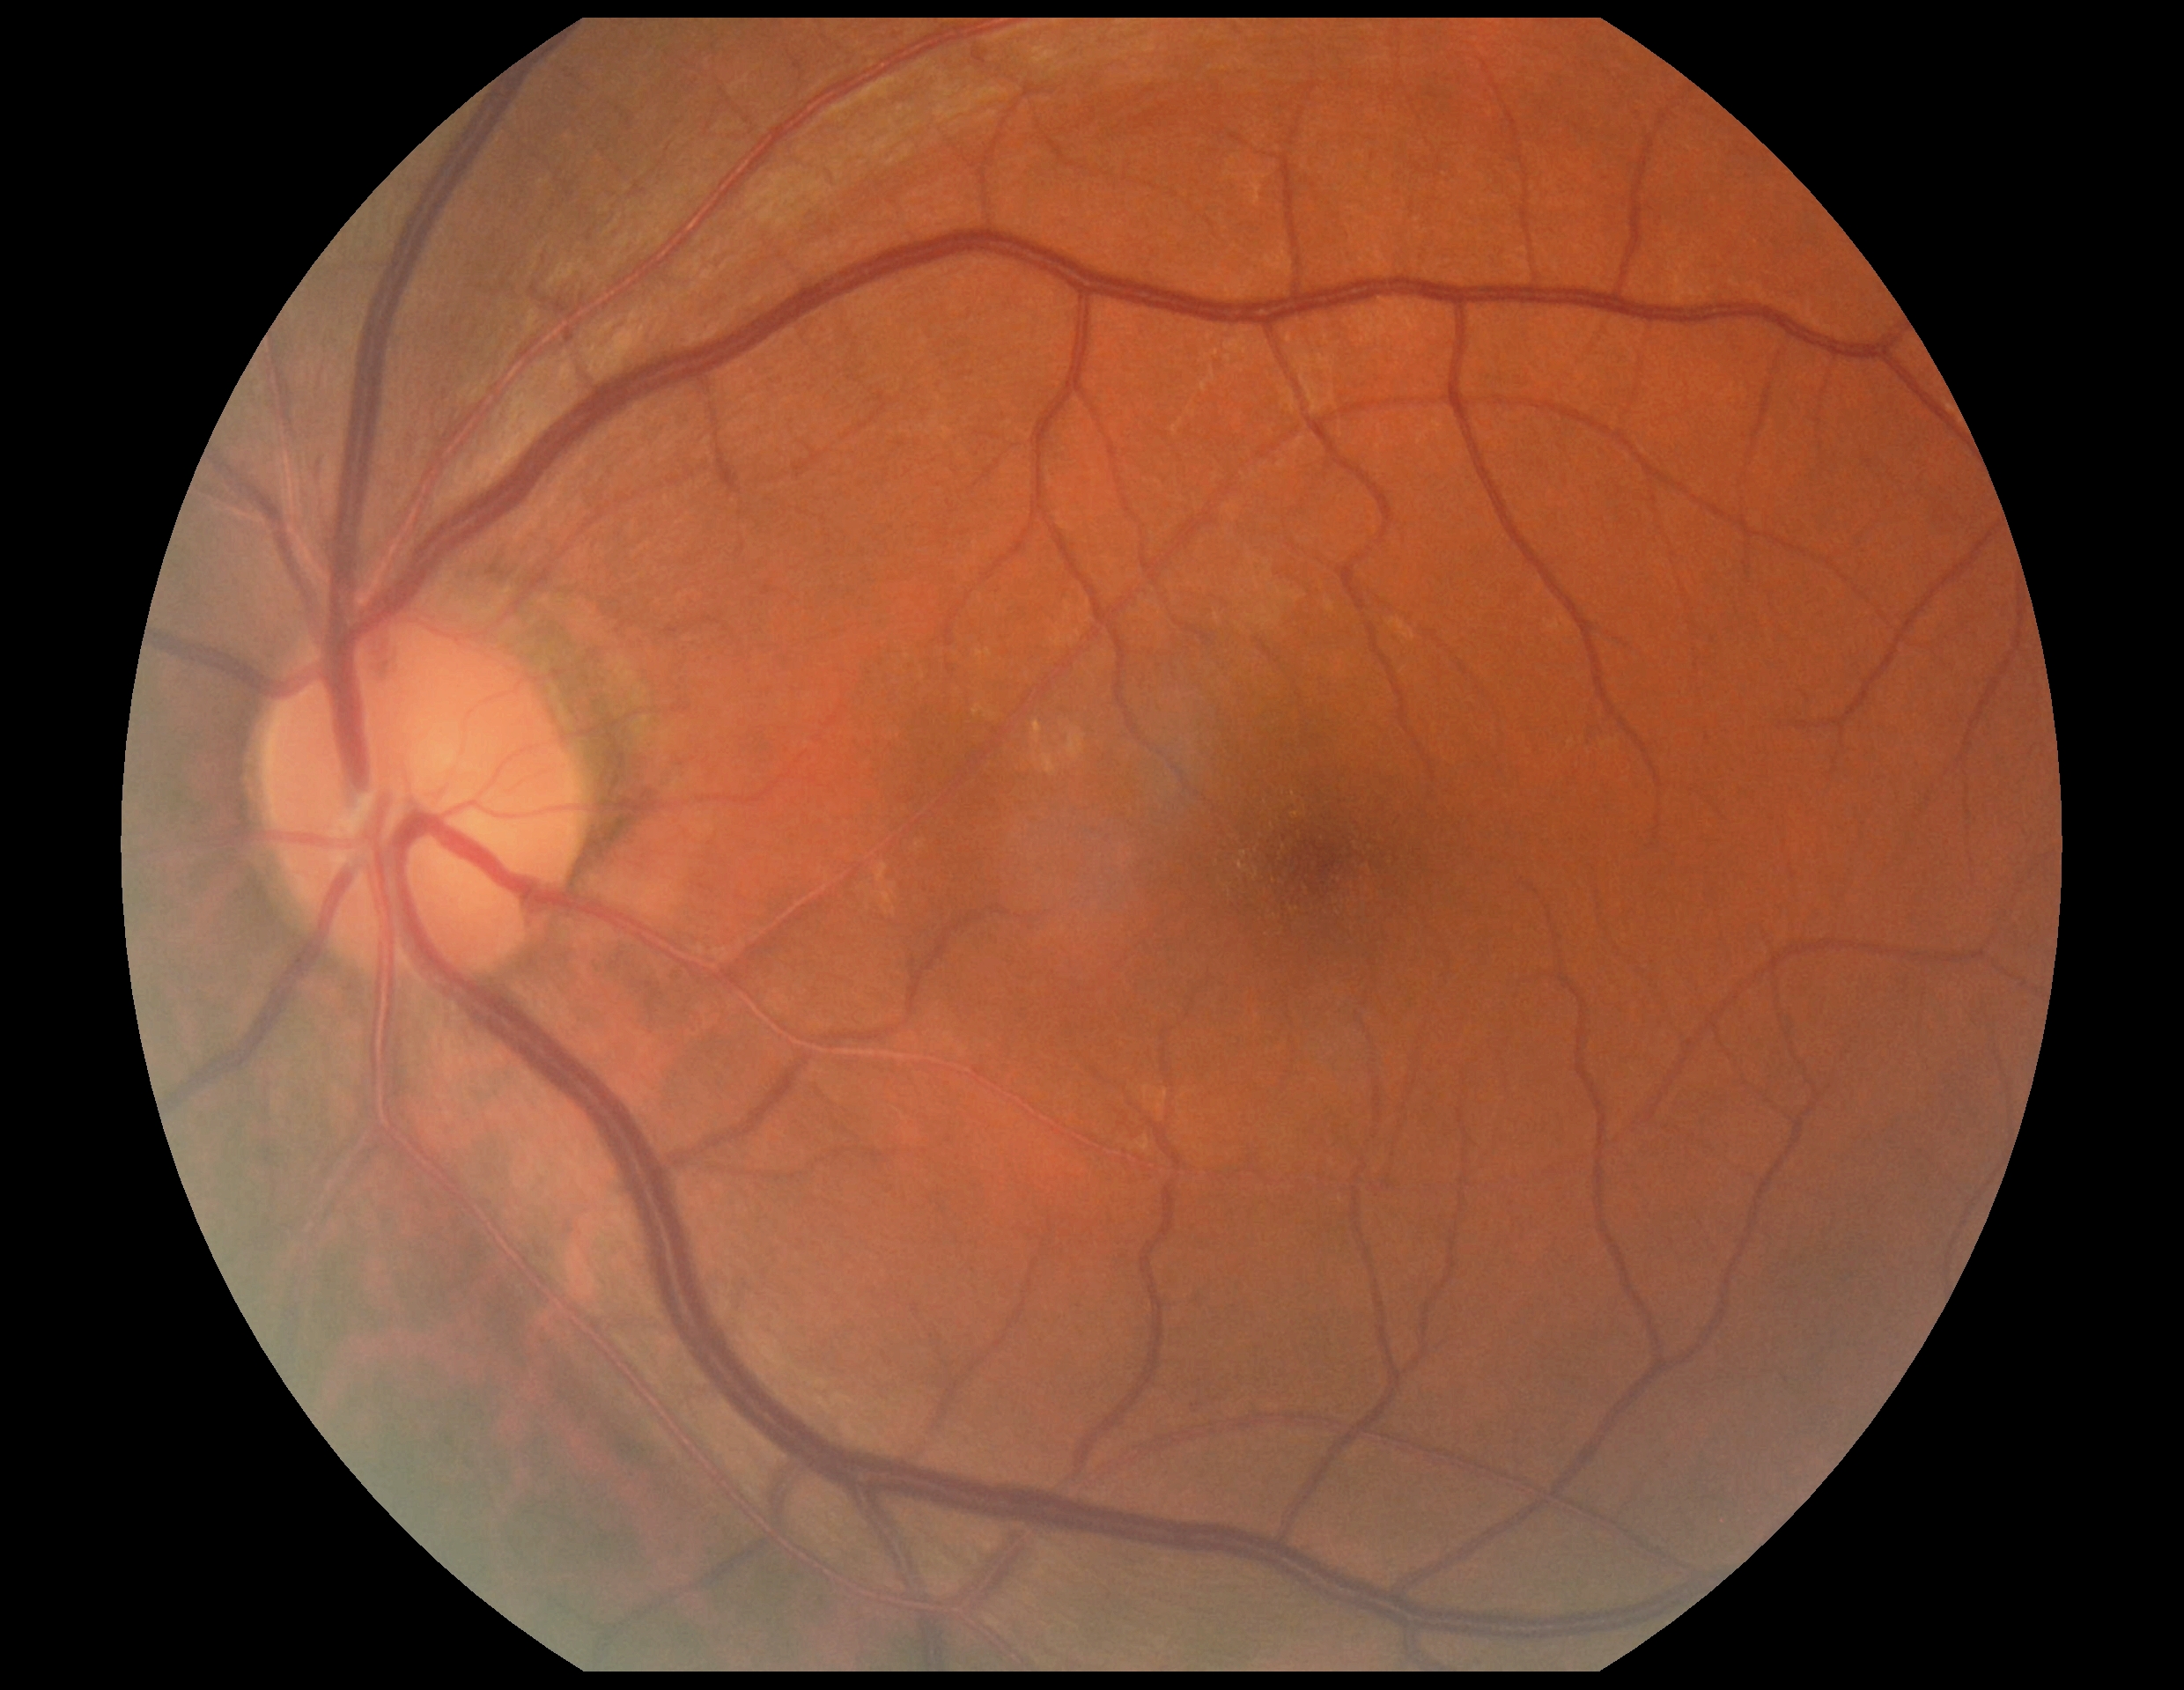

DR: no apparent diabetic retinopathy (grade 0).